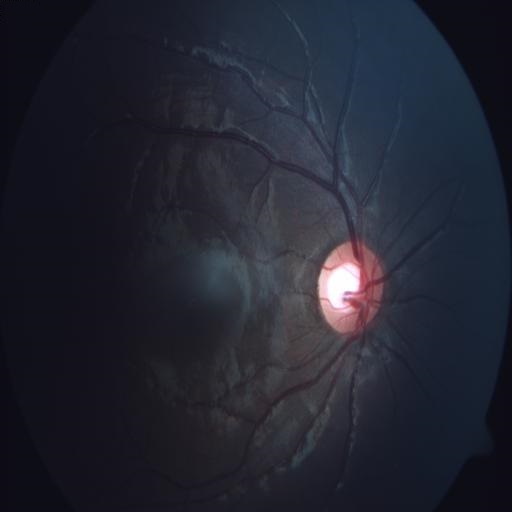
The image shows ODC (optic disc cupping).